Image size 2352x1568. Color fundus image. FOV: 45 degrees:
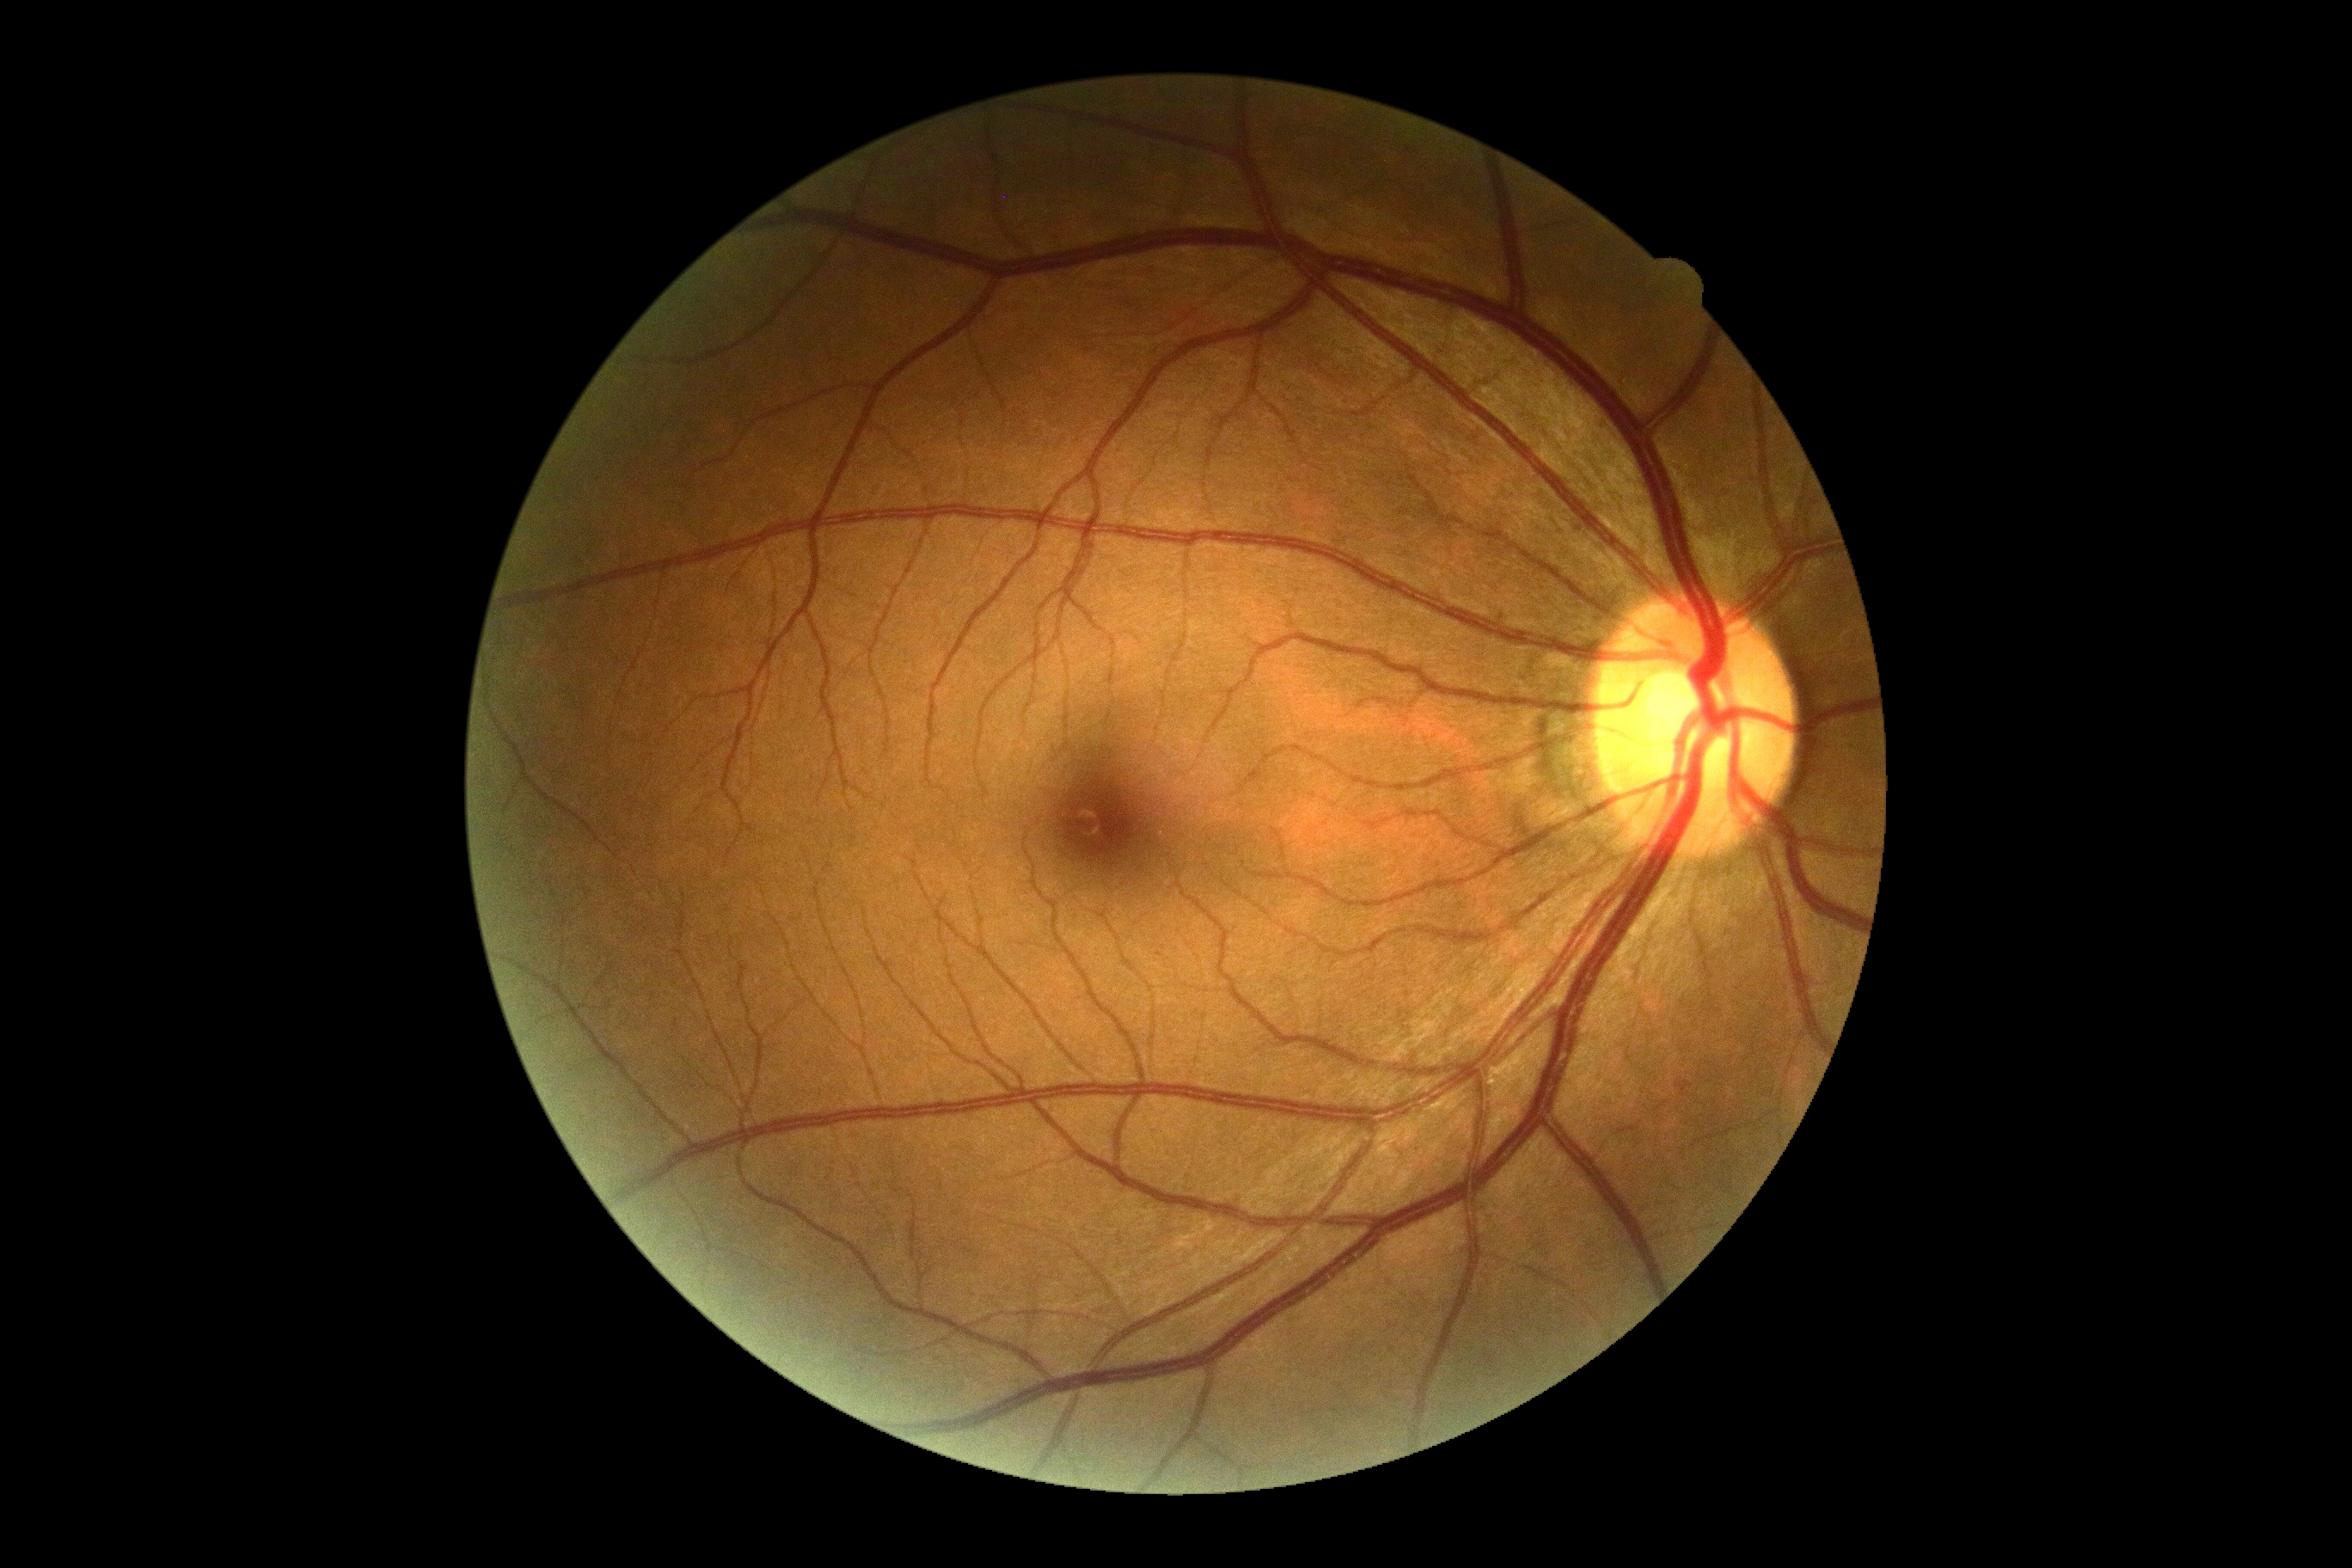
DR = no apparent diabetic retinopathy (grade 0)